Optic disc photograph: 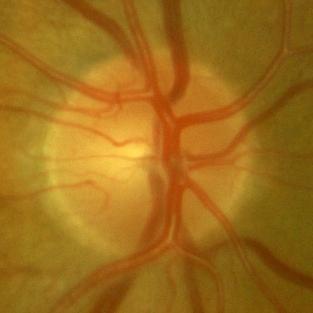
Q: Does this eye have glaucoma?
A: No glaucomatous changes.